Wide-field fundus photograph from neonatal ROP screening; captured with the Clarity RetCam 3 (130° field of view):
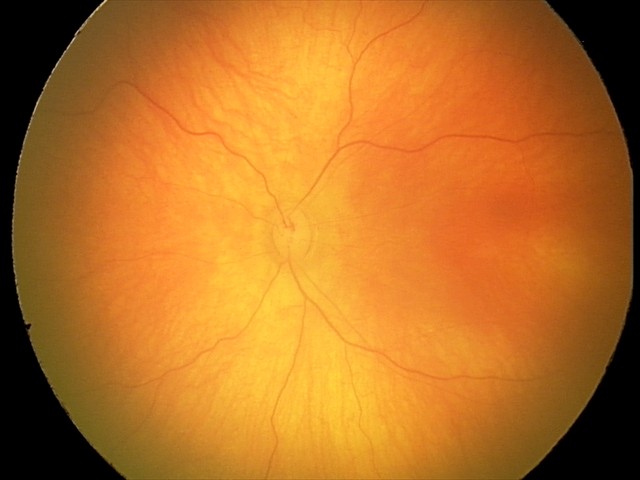 Screening examination with no abnormal retinal findings.